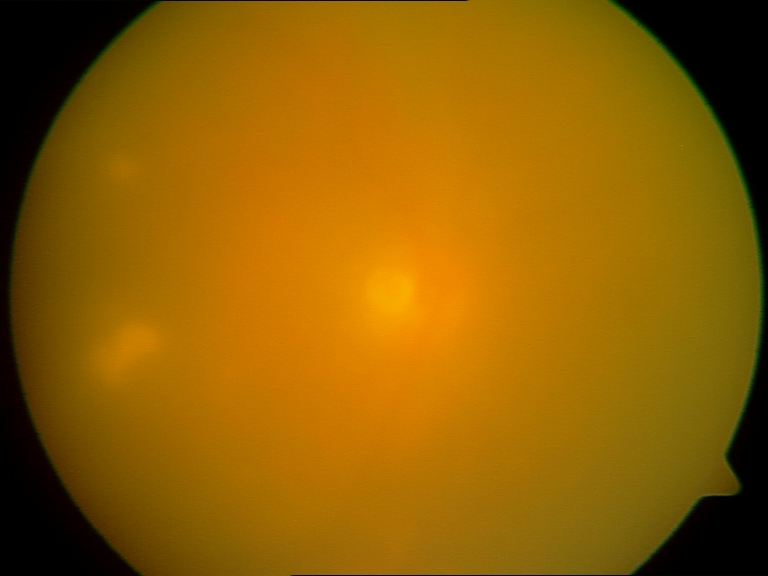

Gradability: poor, substantial obscuration of retinal landmarks.
Proliferative retinopathy: not identified.